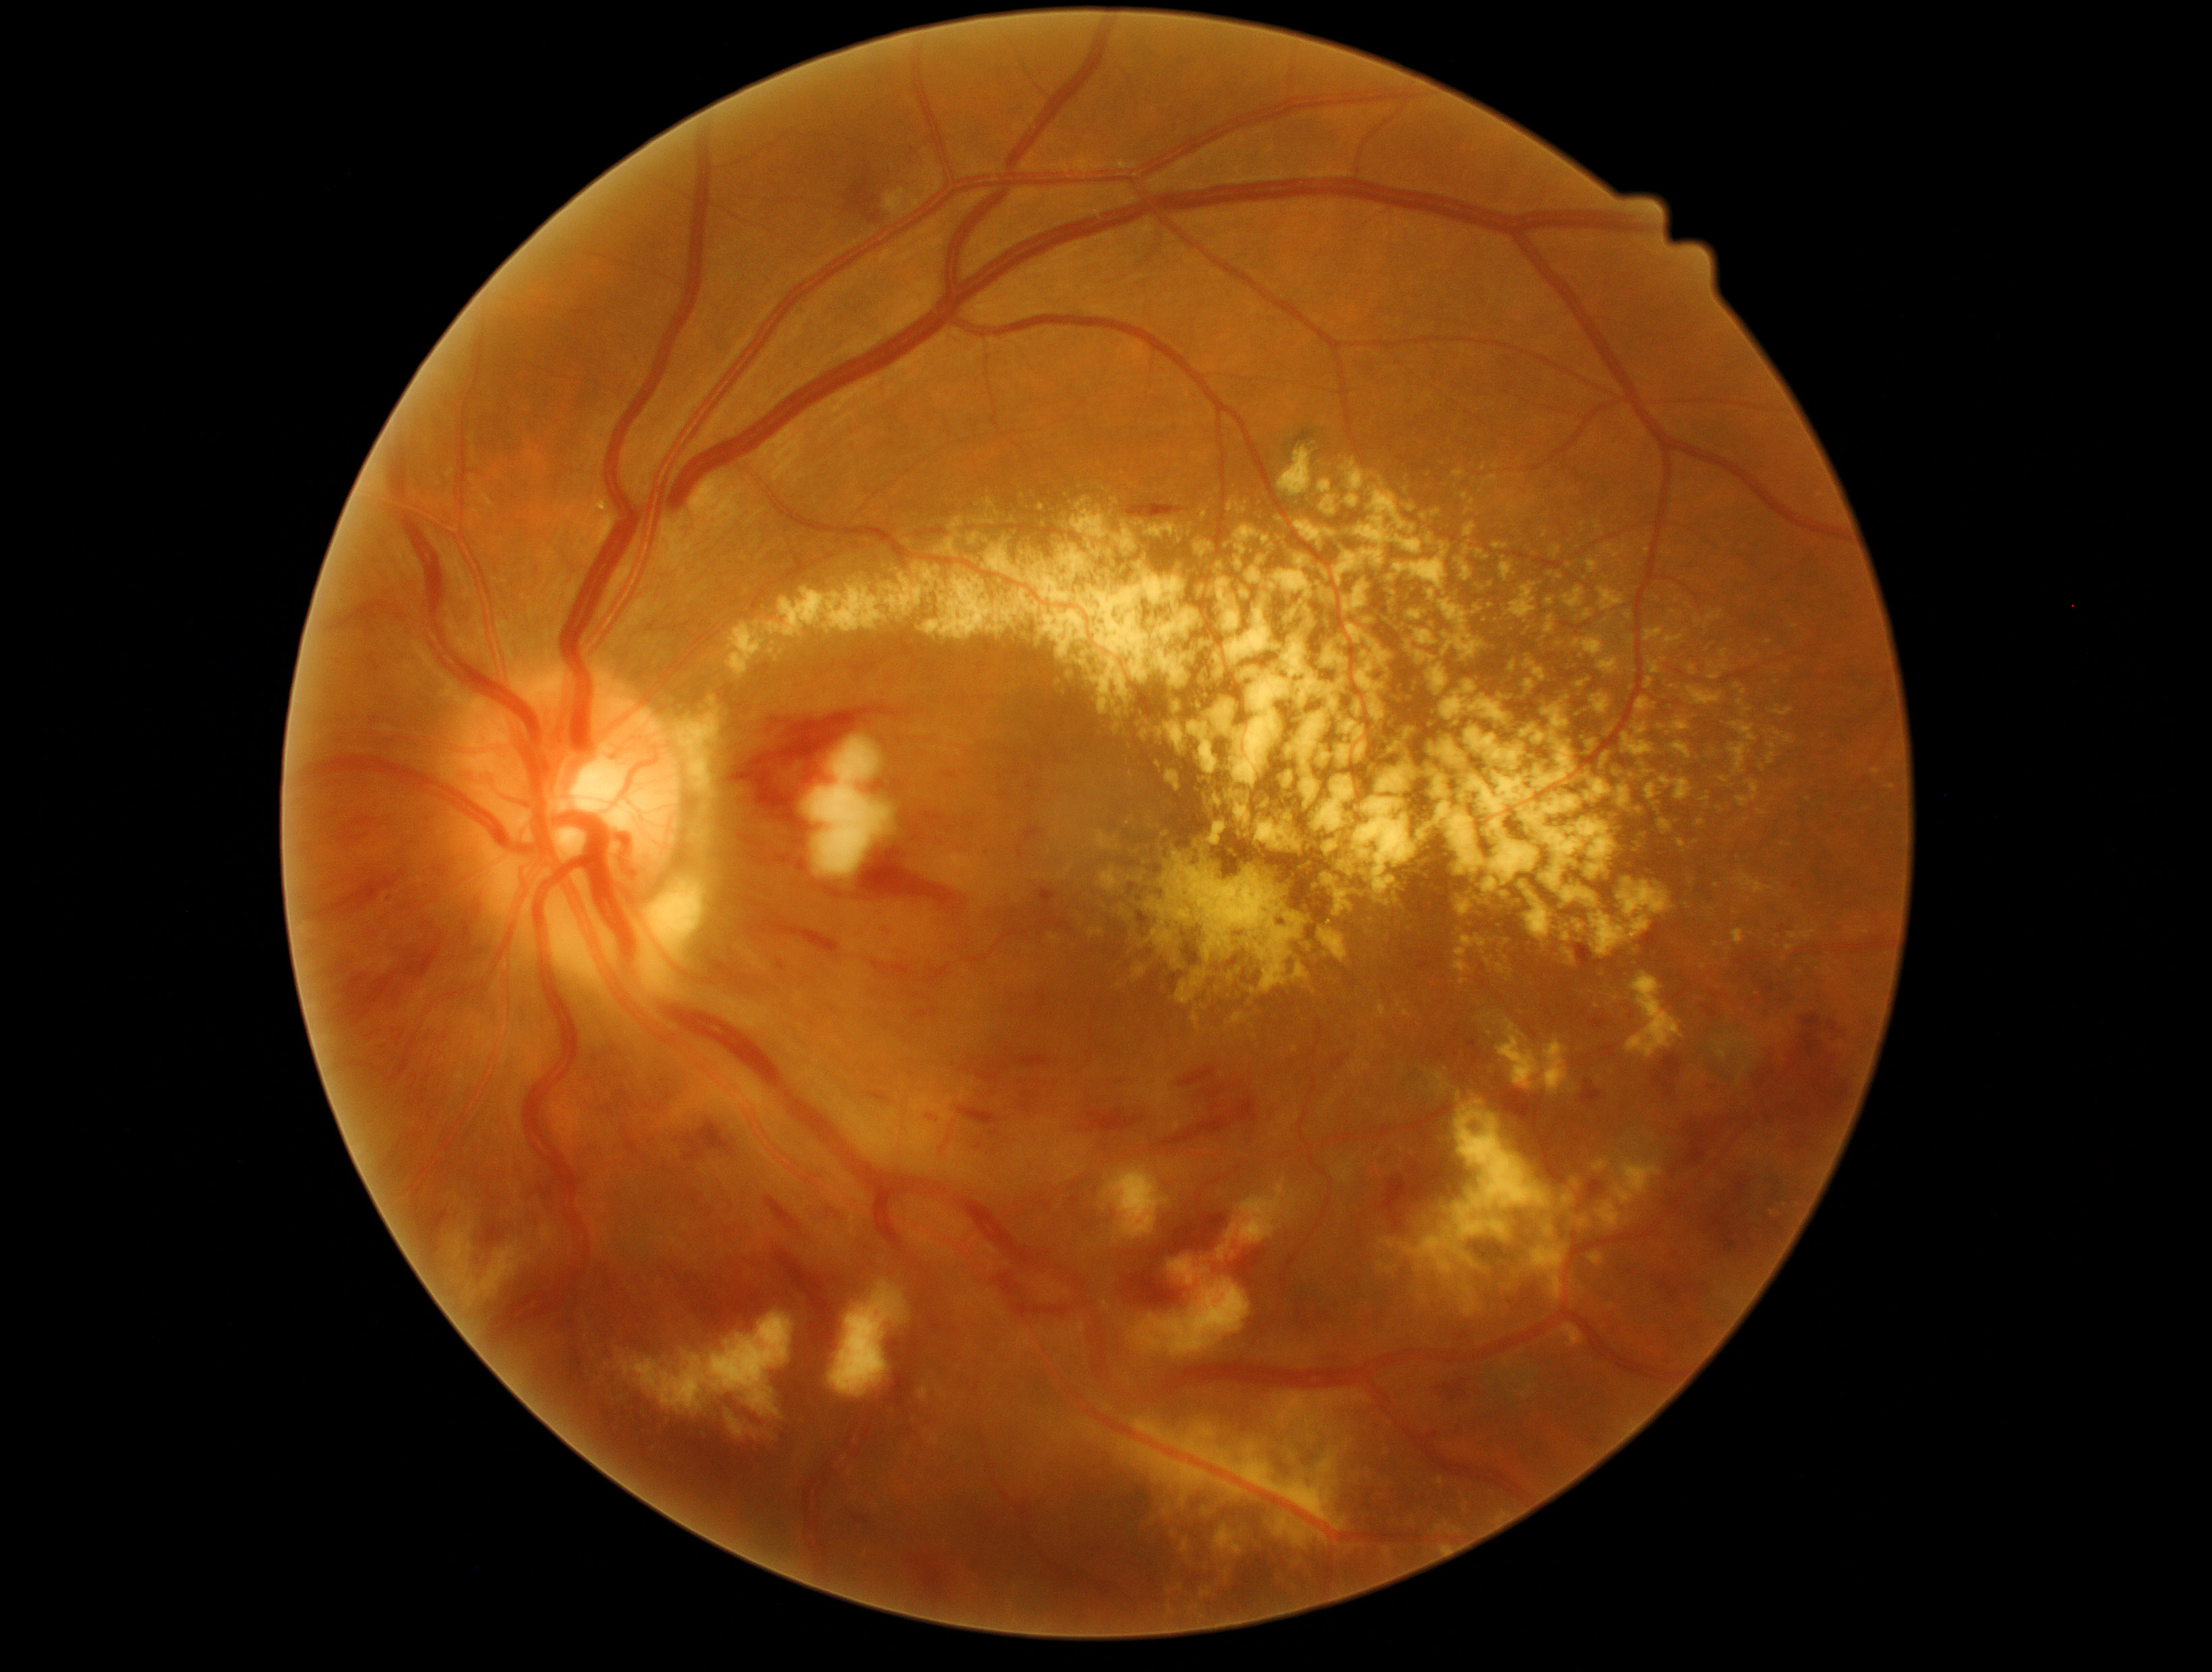

partial: true
dr_grade: 3
lesions:
  ex:
    - 1451, 896, 1476, 920
    - 1438, 675, 1521, 732
    - 1190, 1588, 1212, 1624
    - 1084, 1421, 1105, 1445
    - 1502, 1252, 1525, 1301
    - 1420, 761, 1509, 907
    - 1192, 777, 1209, 795
    - 1768, 753, 1776, 765
    - 987, 498, 1000, 517
    - 1537, 528, 1546, 541
    - 1560, 663, 1580, 674
    - 1341, 456, 1387, 490
    - 1275, 438, 1313, 501
    - 1631, 827, 1648, 854
    - 1676, 838, 1689, 852
    - 1871, 769, 1882, 775
  ex_small:
    - x=1060 y=580
    - x=1736 y=912
    - x=1636 y=1147